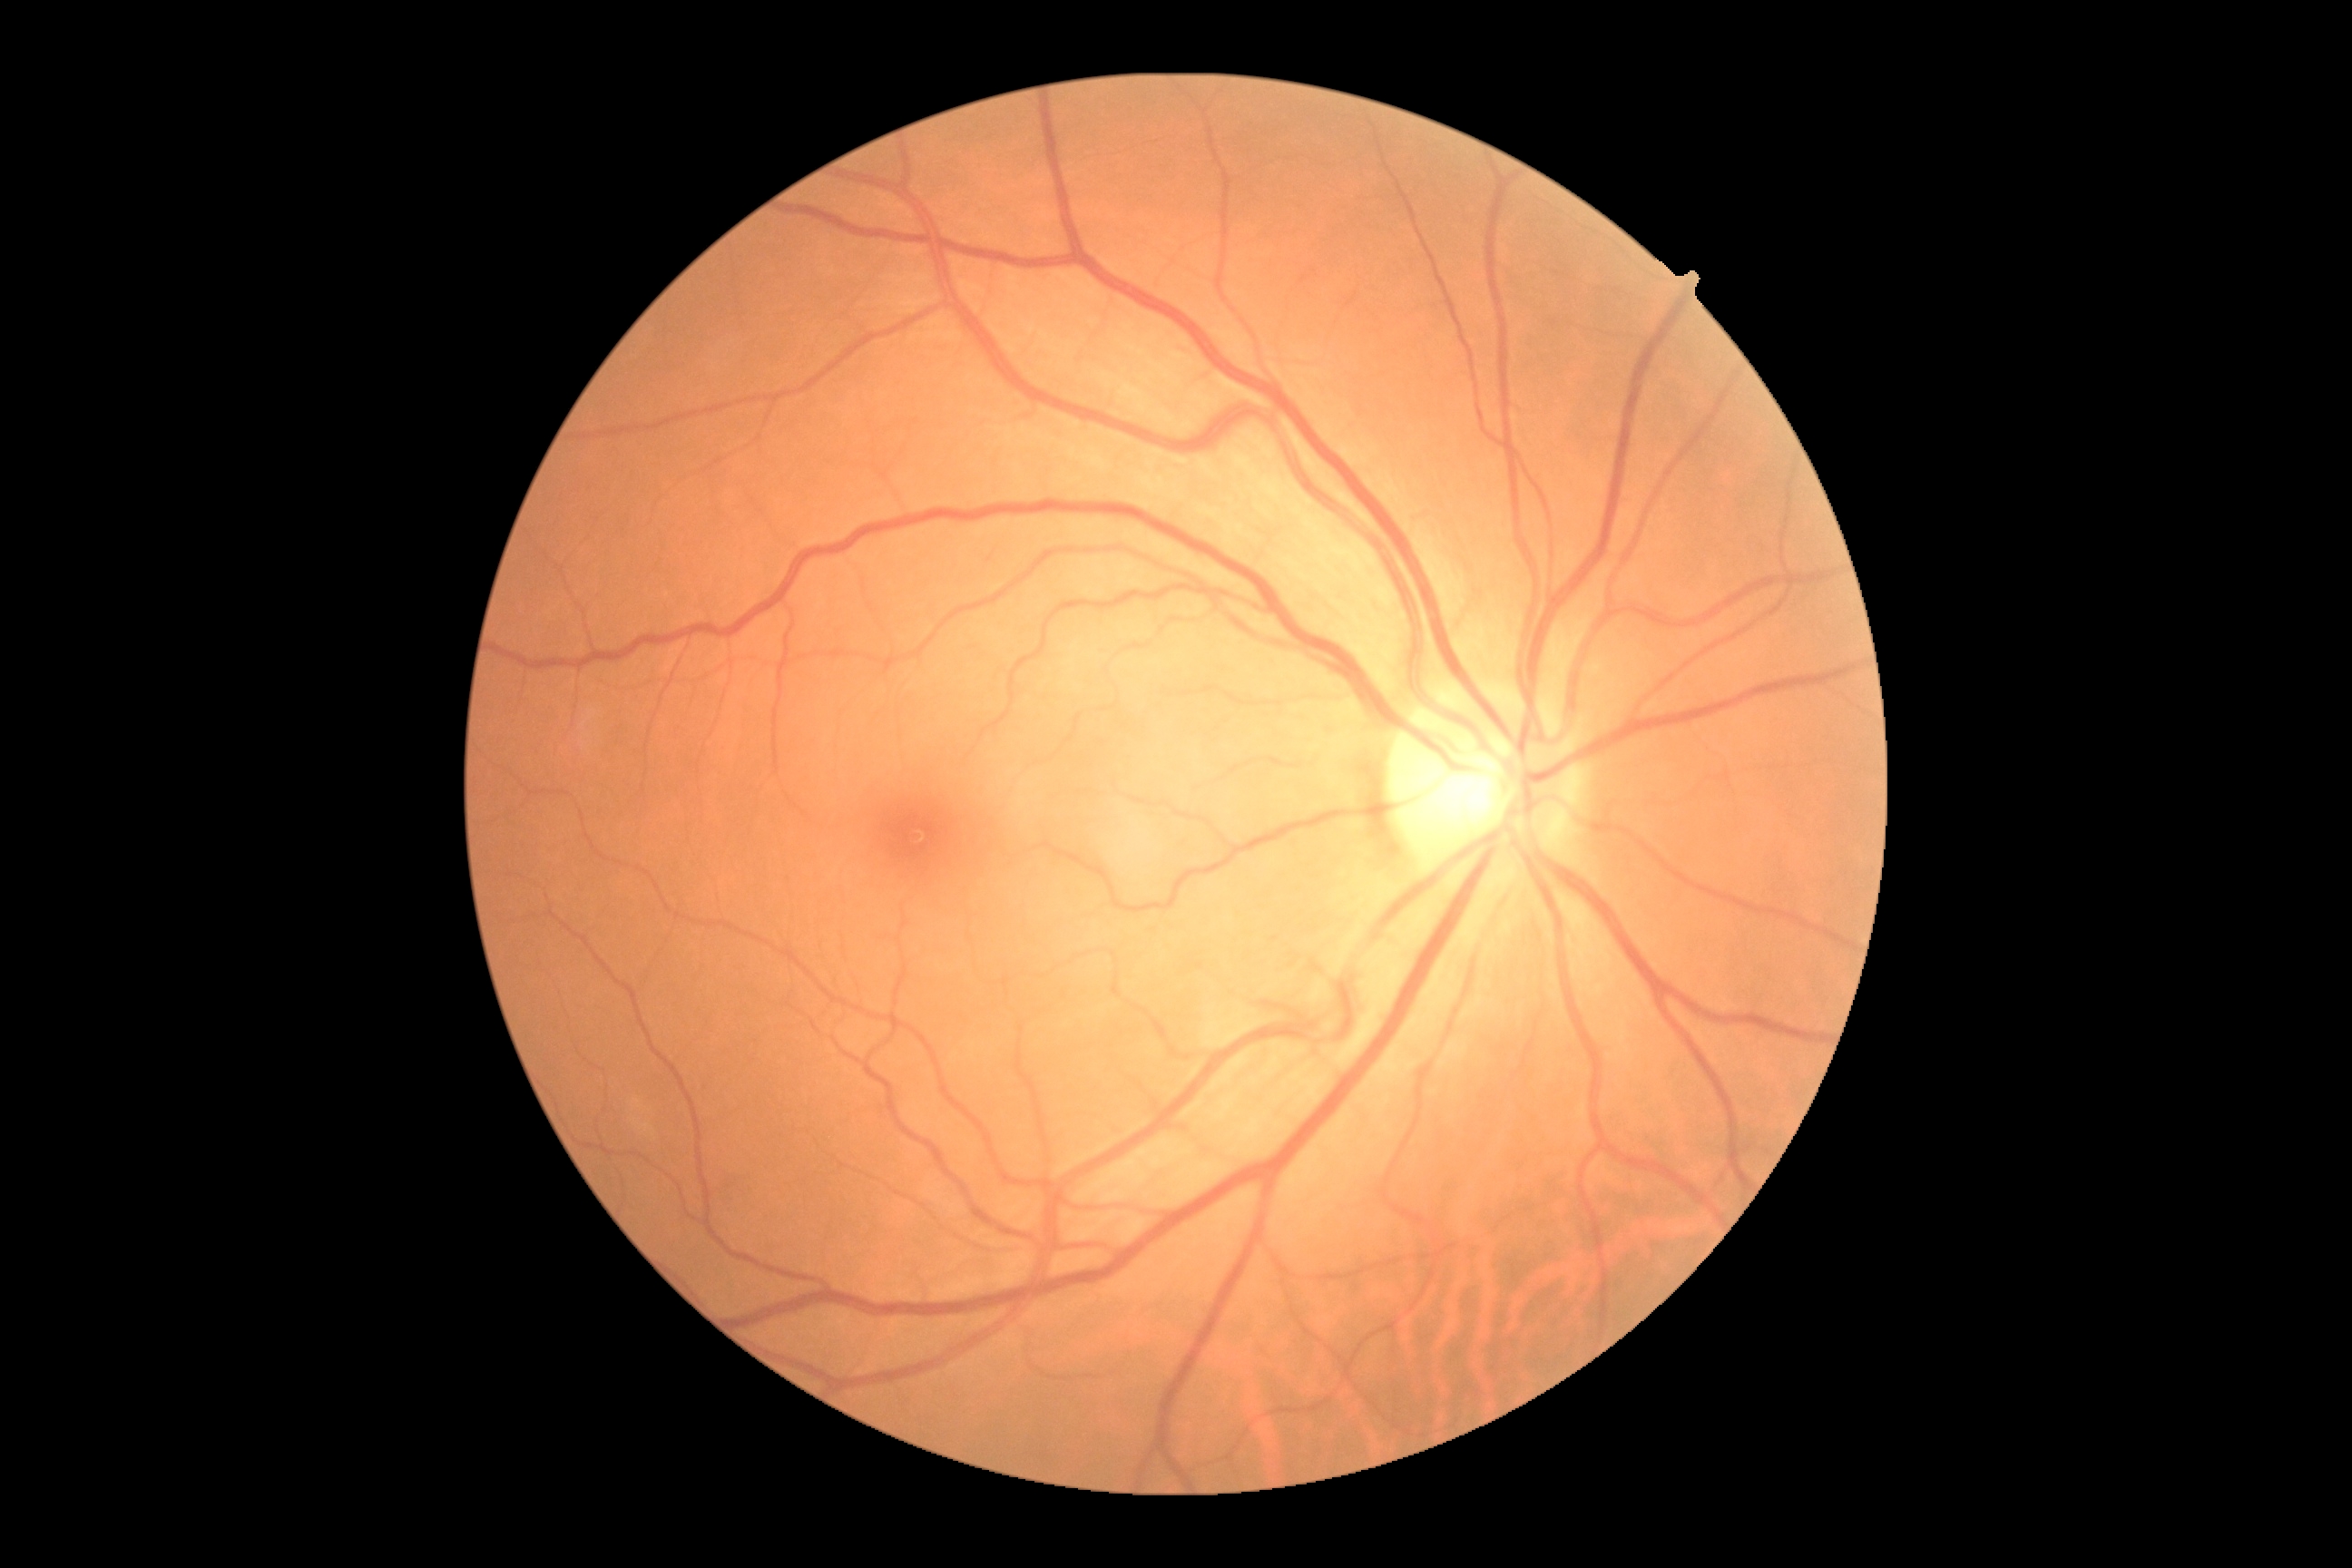

• DR grade — no apparent diabetic retinopathy (0)